Captured with pupil dilation · Topcon TRC fundus camera · fundus photograph cropped around the optic nerve head
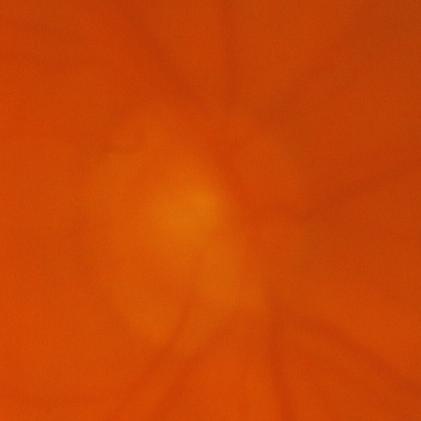
Glaucoma is present. Diagnosis: glaucomatous optic neuropathy.